FOV: 45 degrees · color fundus image · 2212x1659px
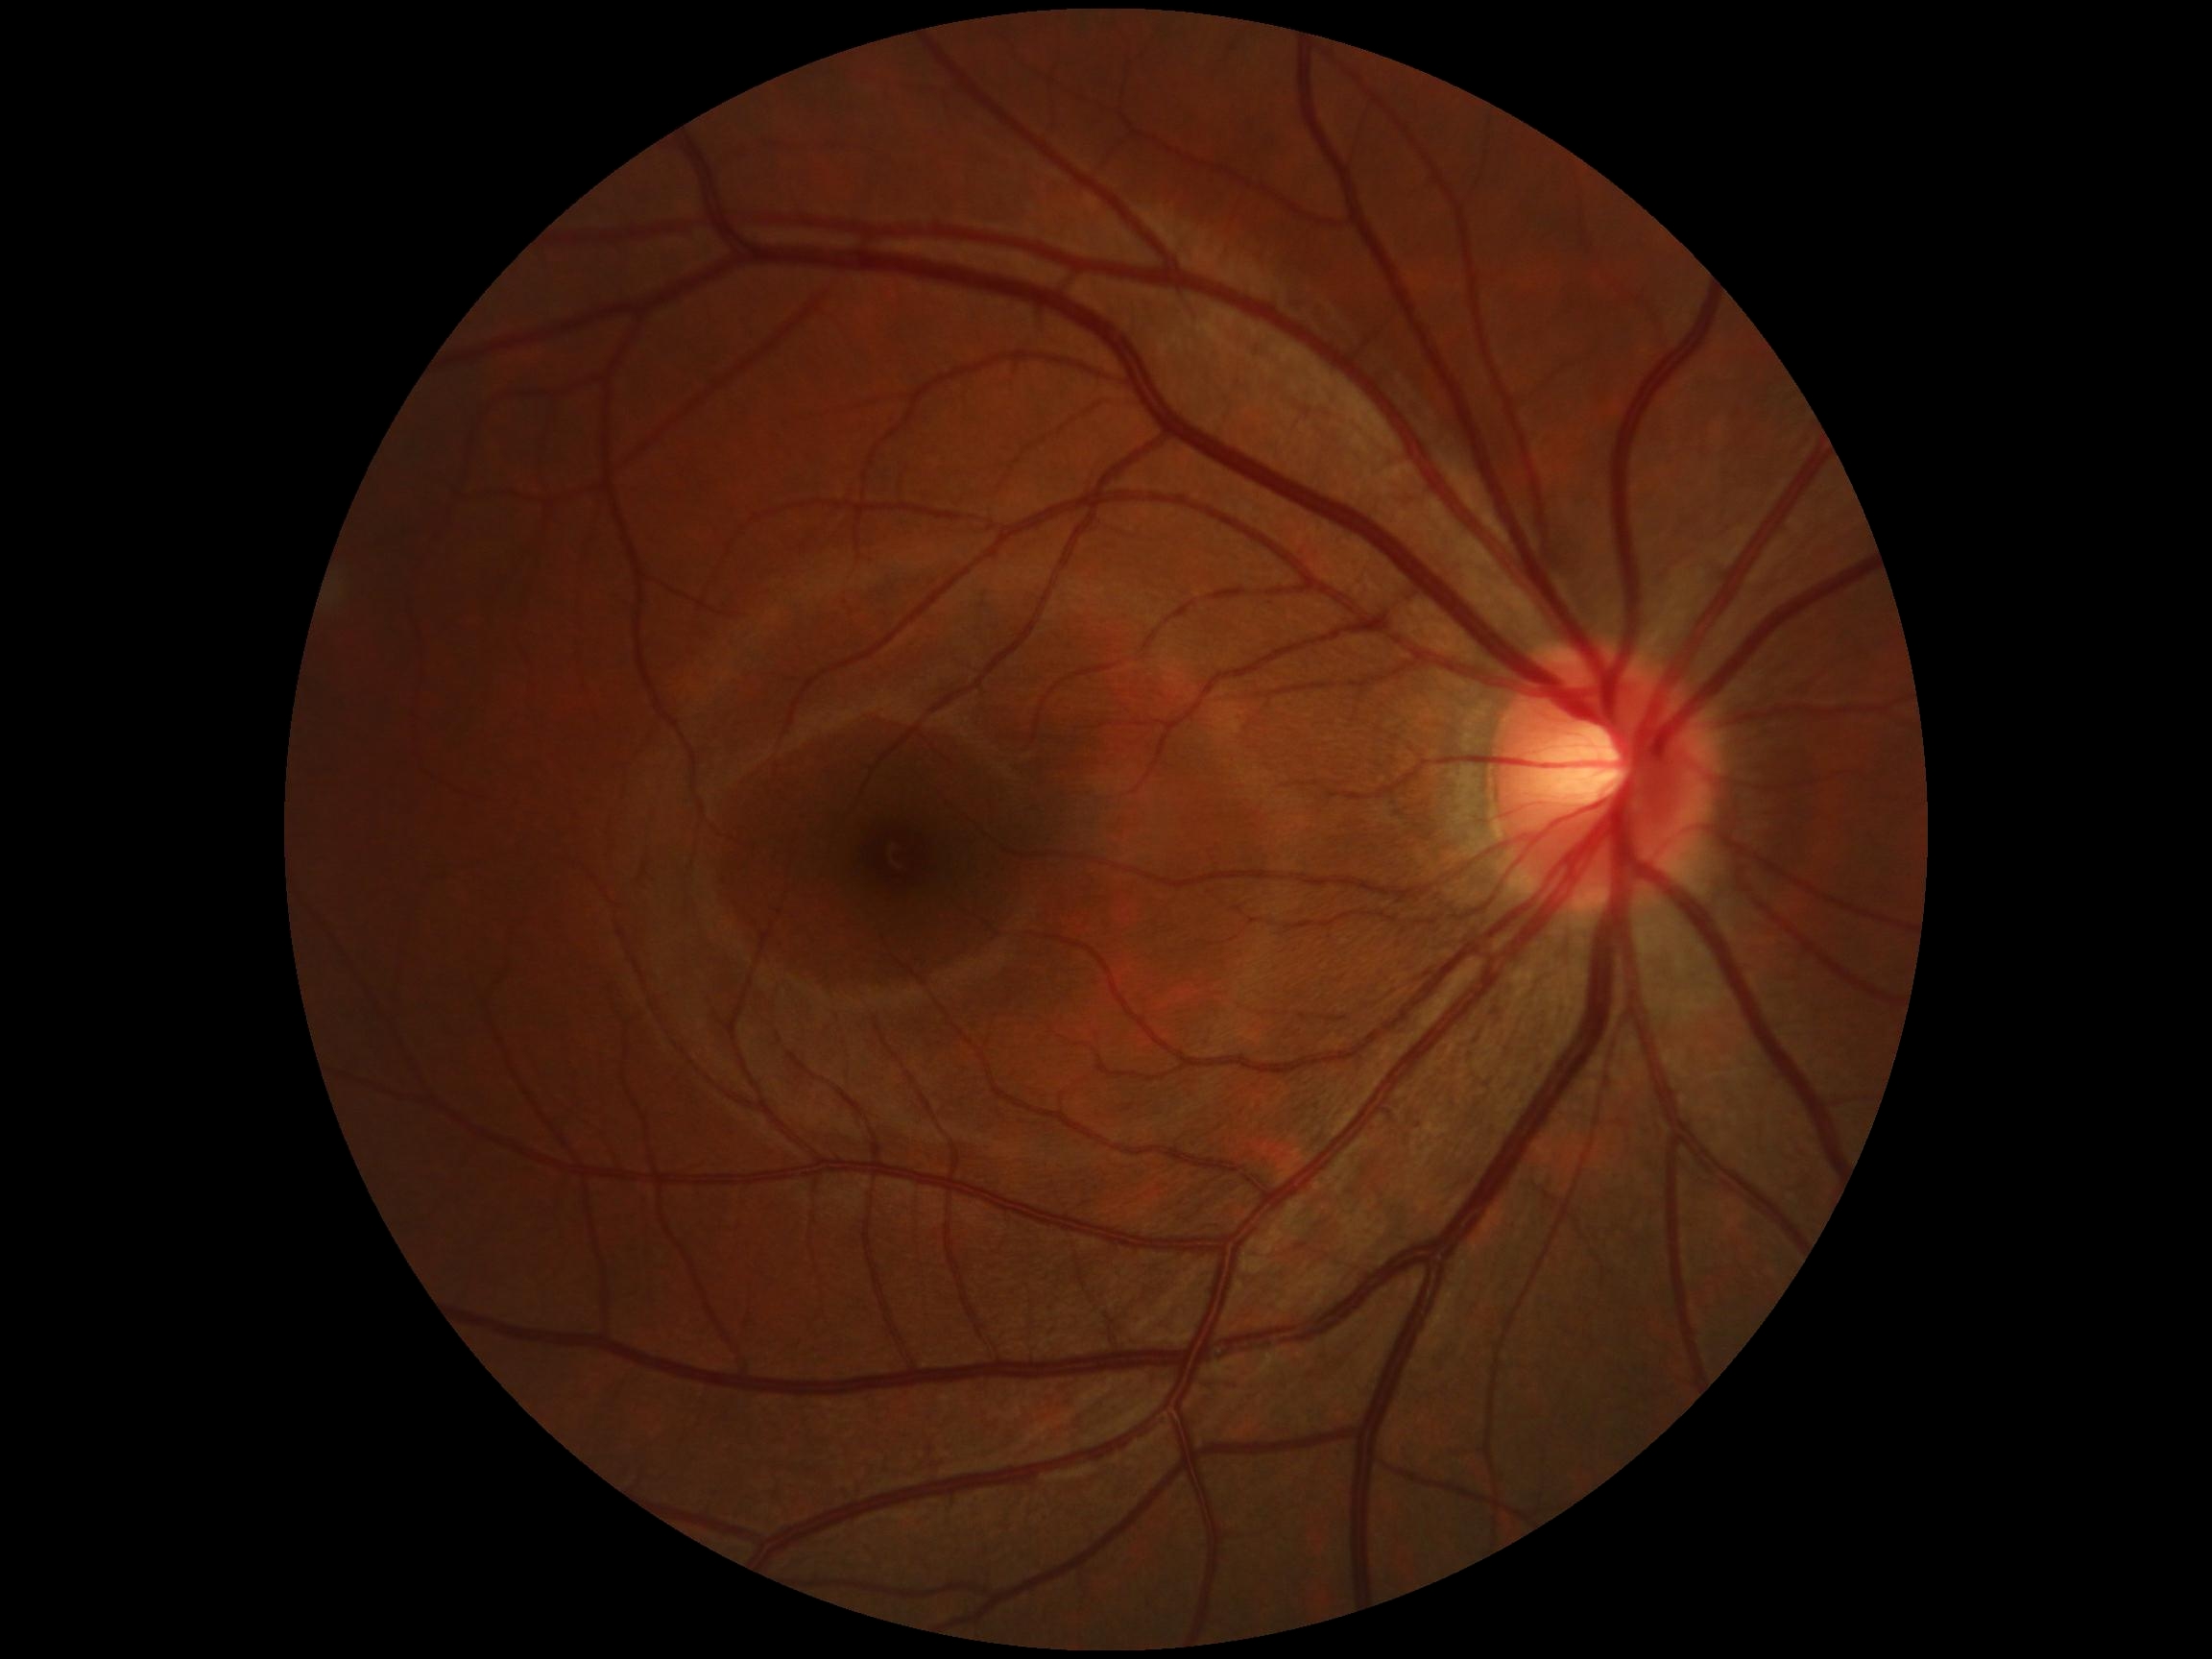

No DR findings.
Diabetic retinopathy (DR) is 0/4.